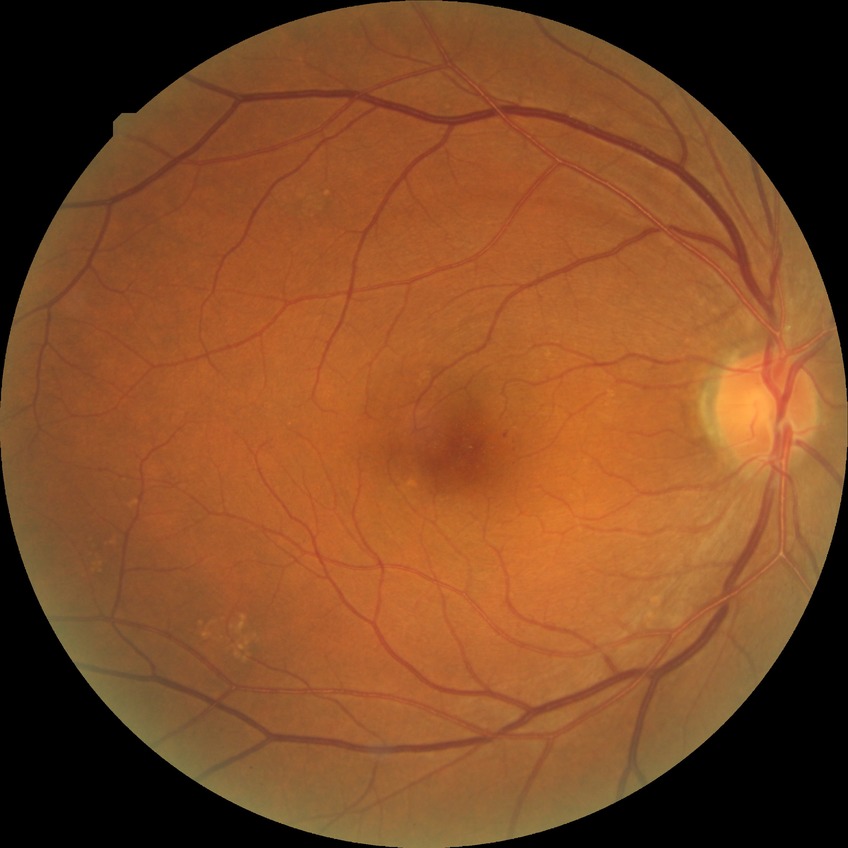 diabetic retinopathy (DR): simple diabetic retinopathy (SDR).